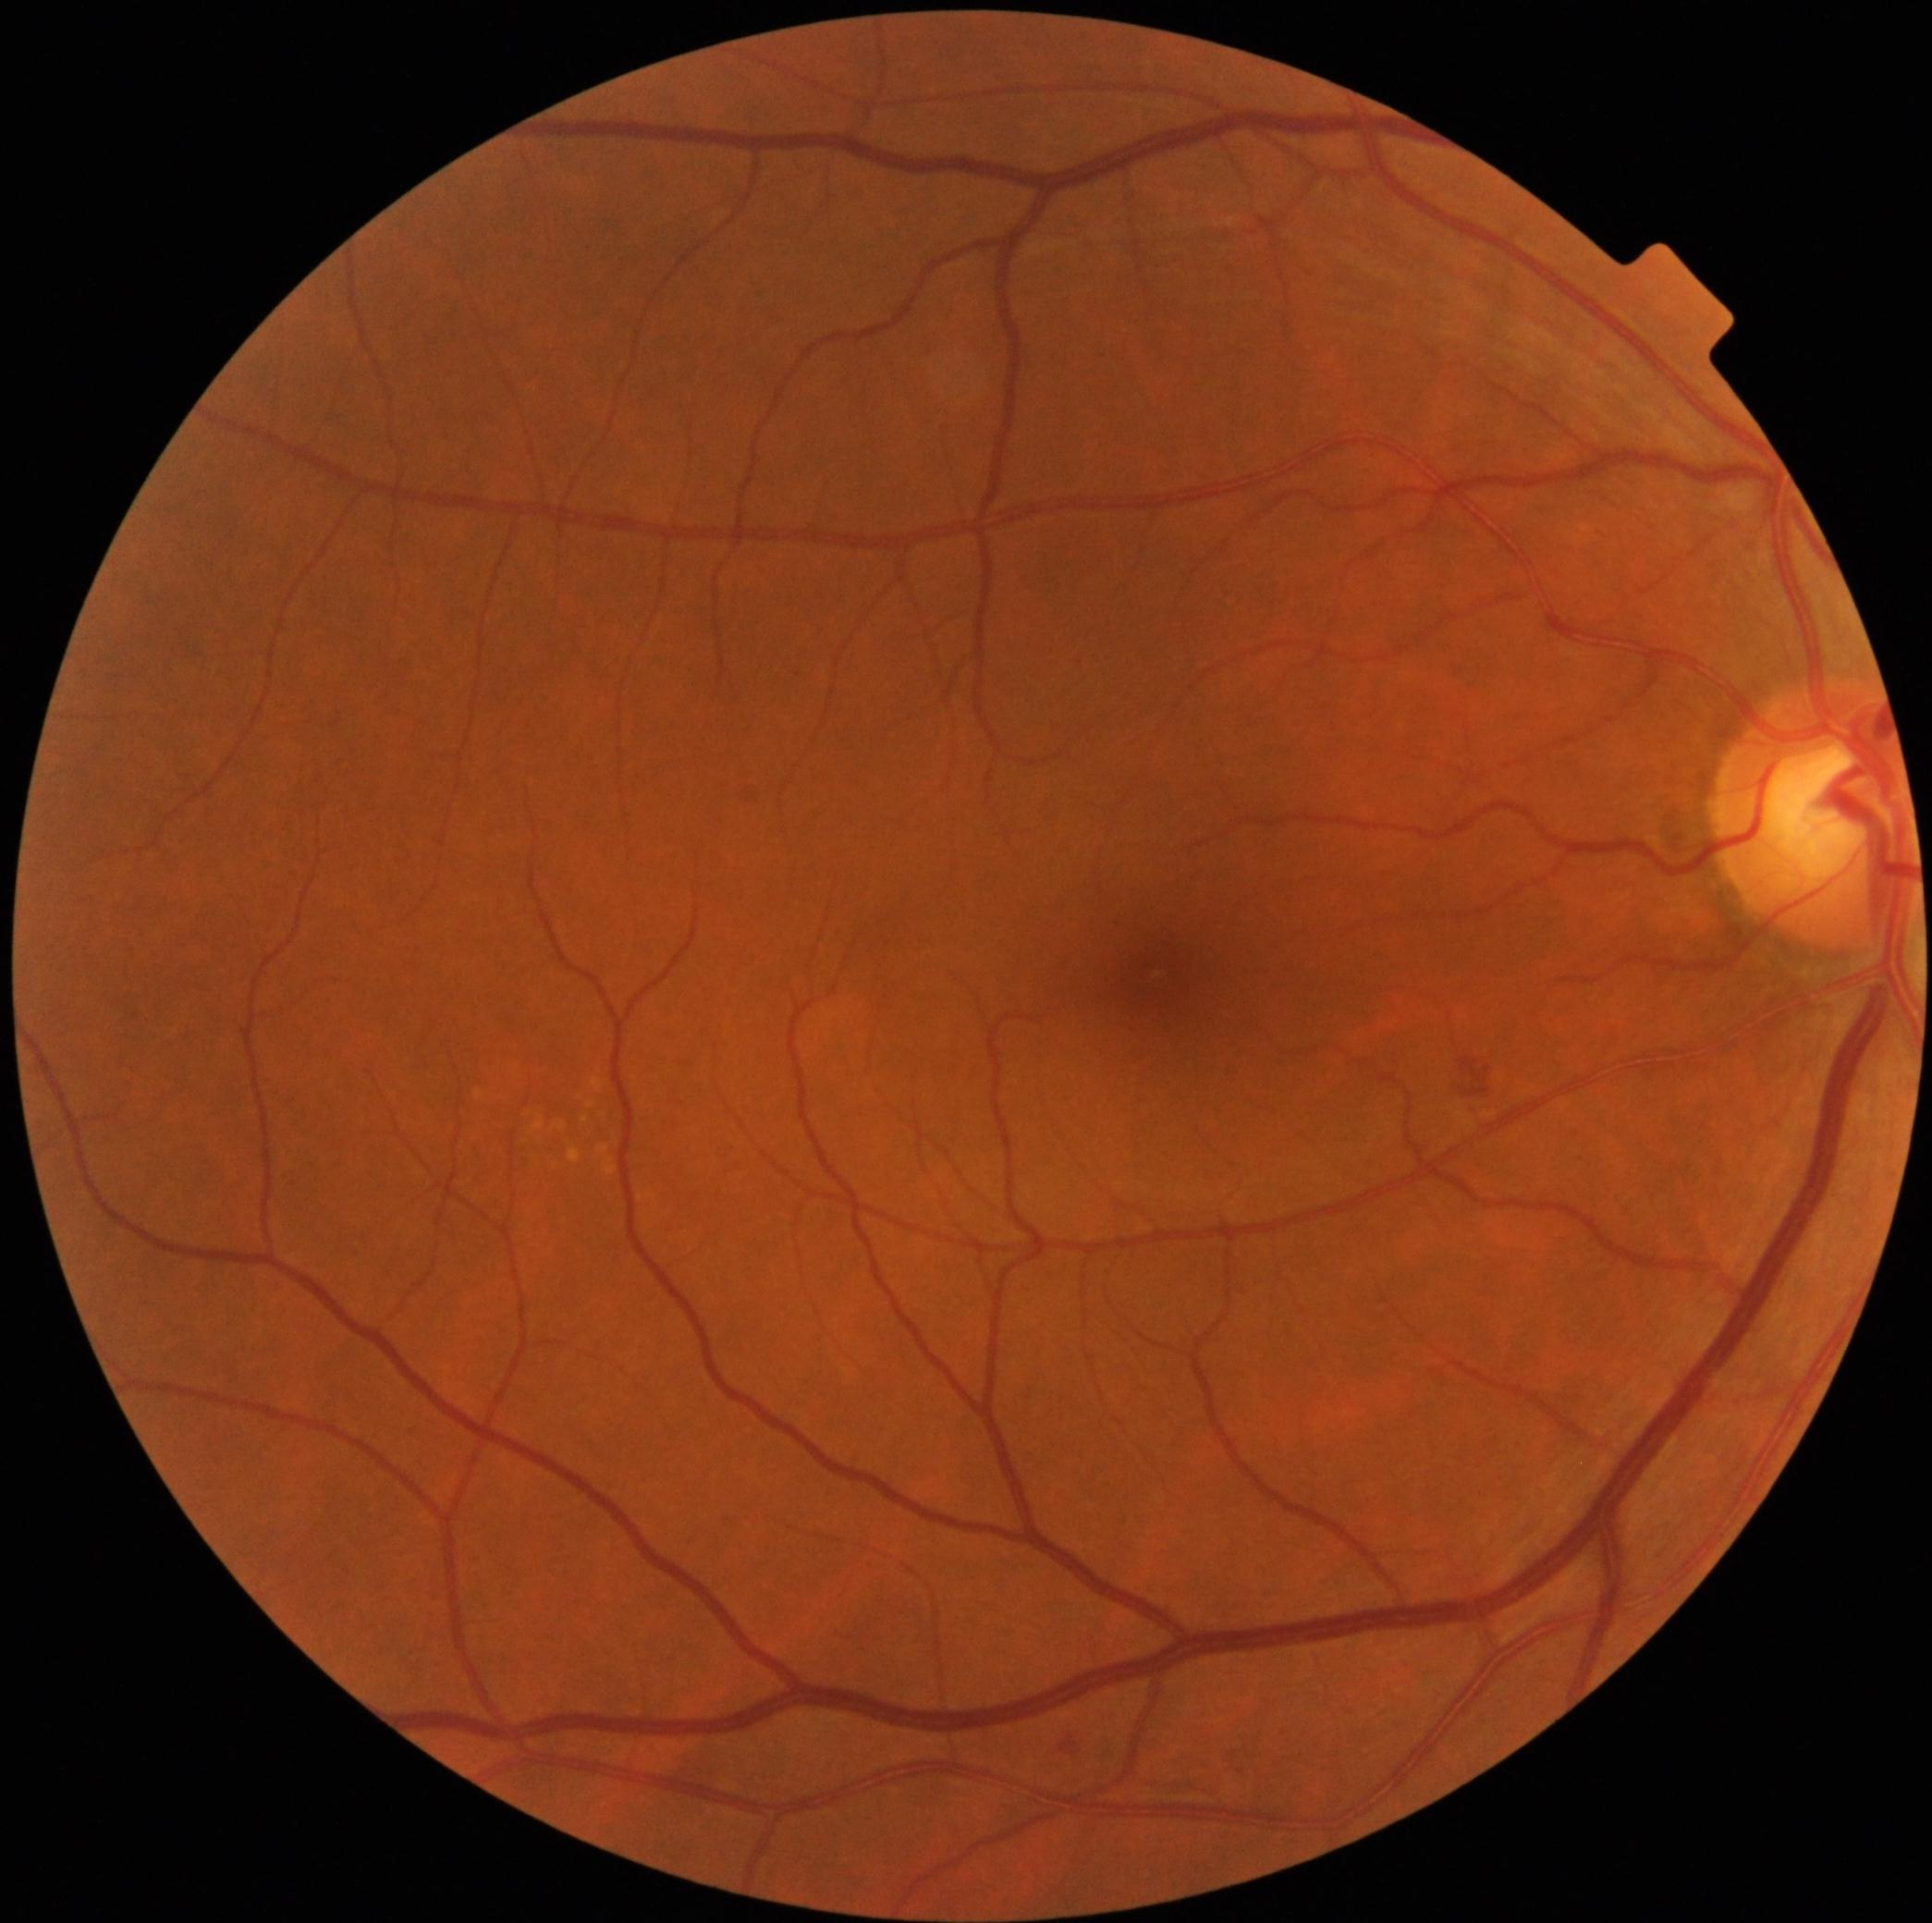

Diabetic retinopathy grade is 2 — more than just microaneurysms but less than severe NPDR.